848 by 848 pixels, 45° field of view — 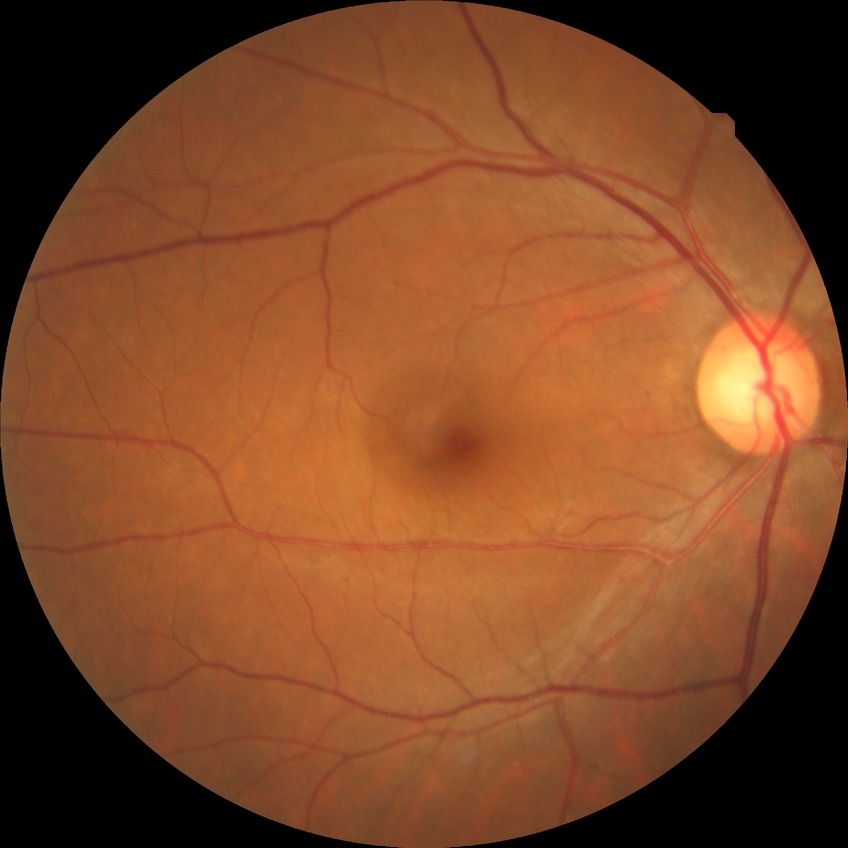
diabetic retinopathy stage = no diabetic retinopathy.